1440 by 1080 pixels; infant wide-field retinal image: 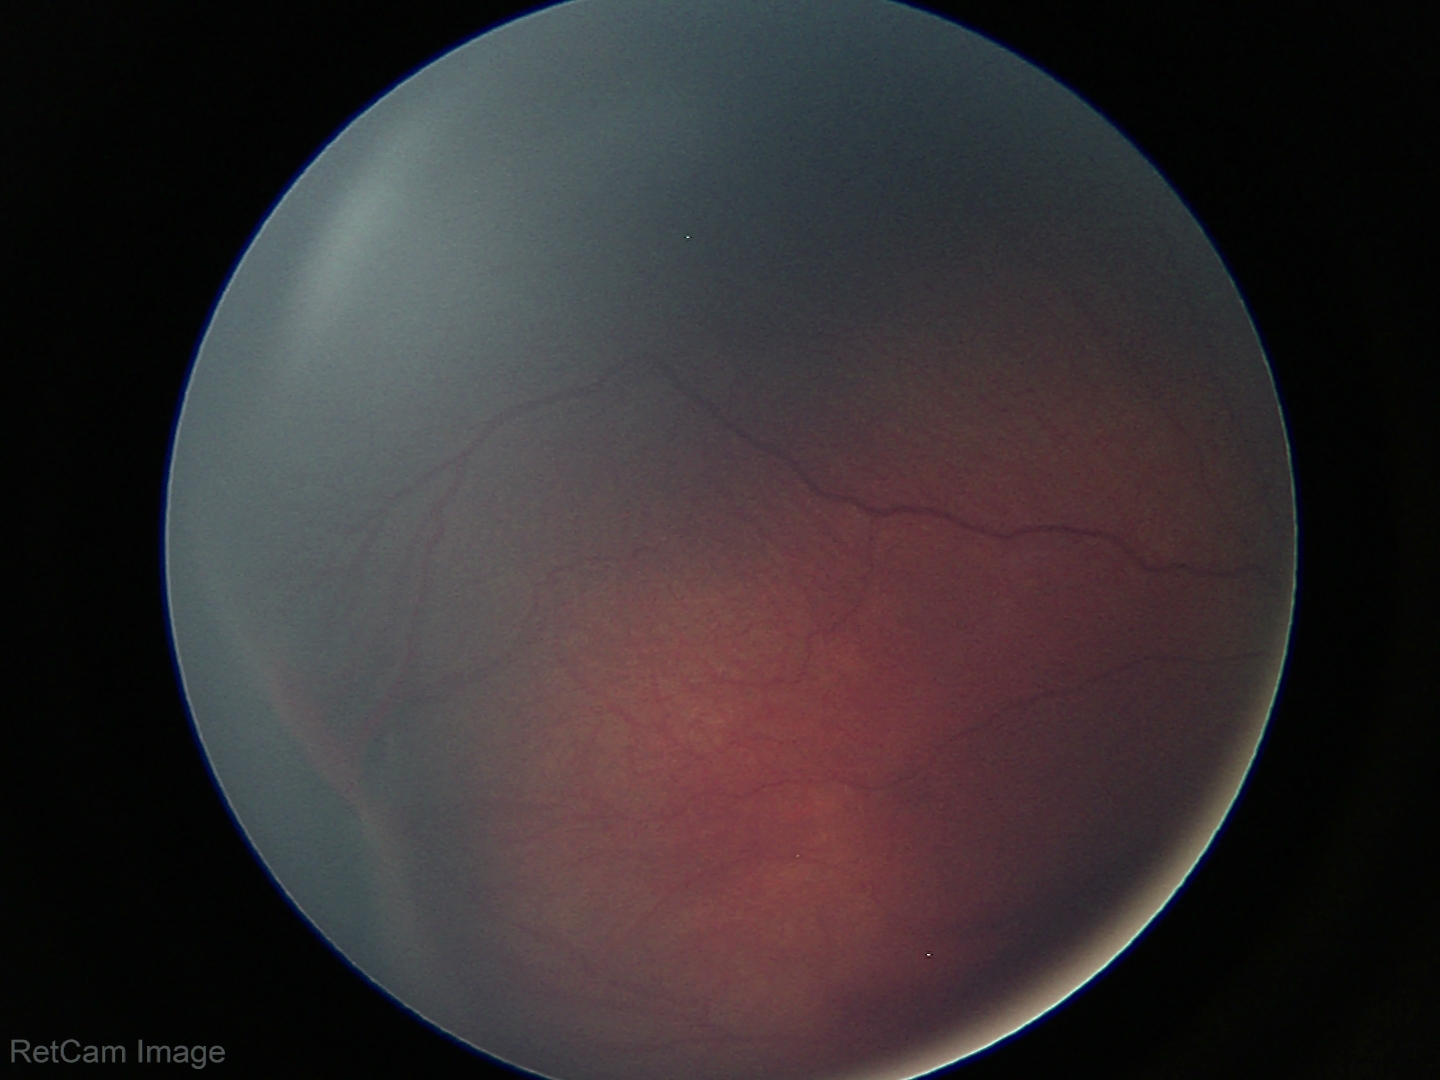

No plus disease.
Screening examination consistent with retinopathy of prematurity stage 3.